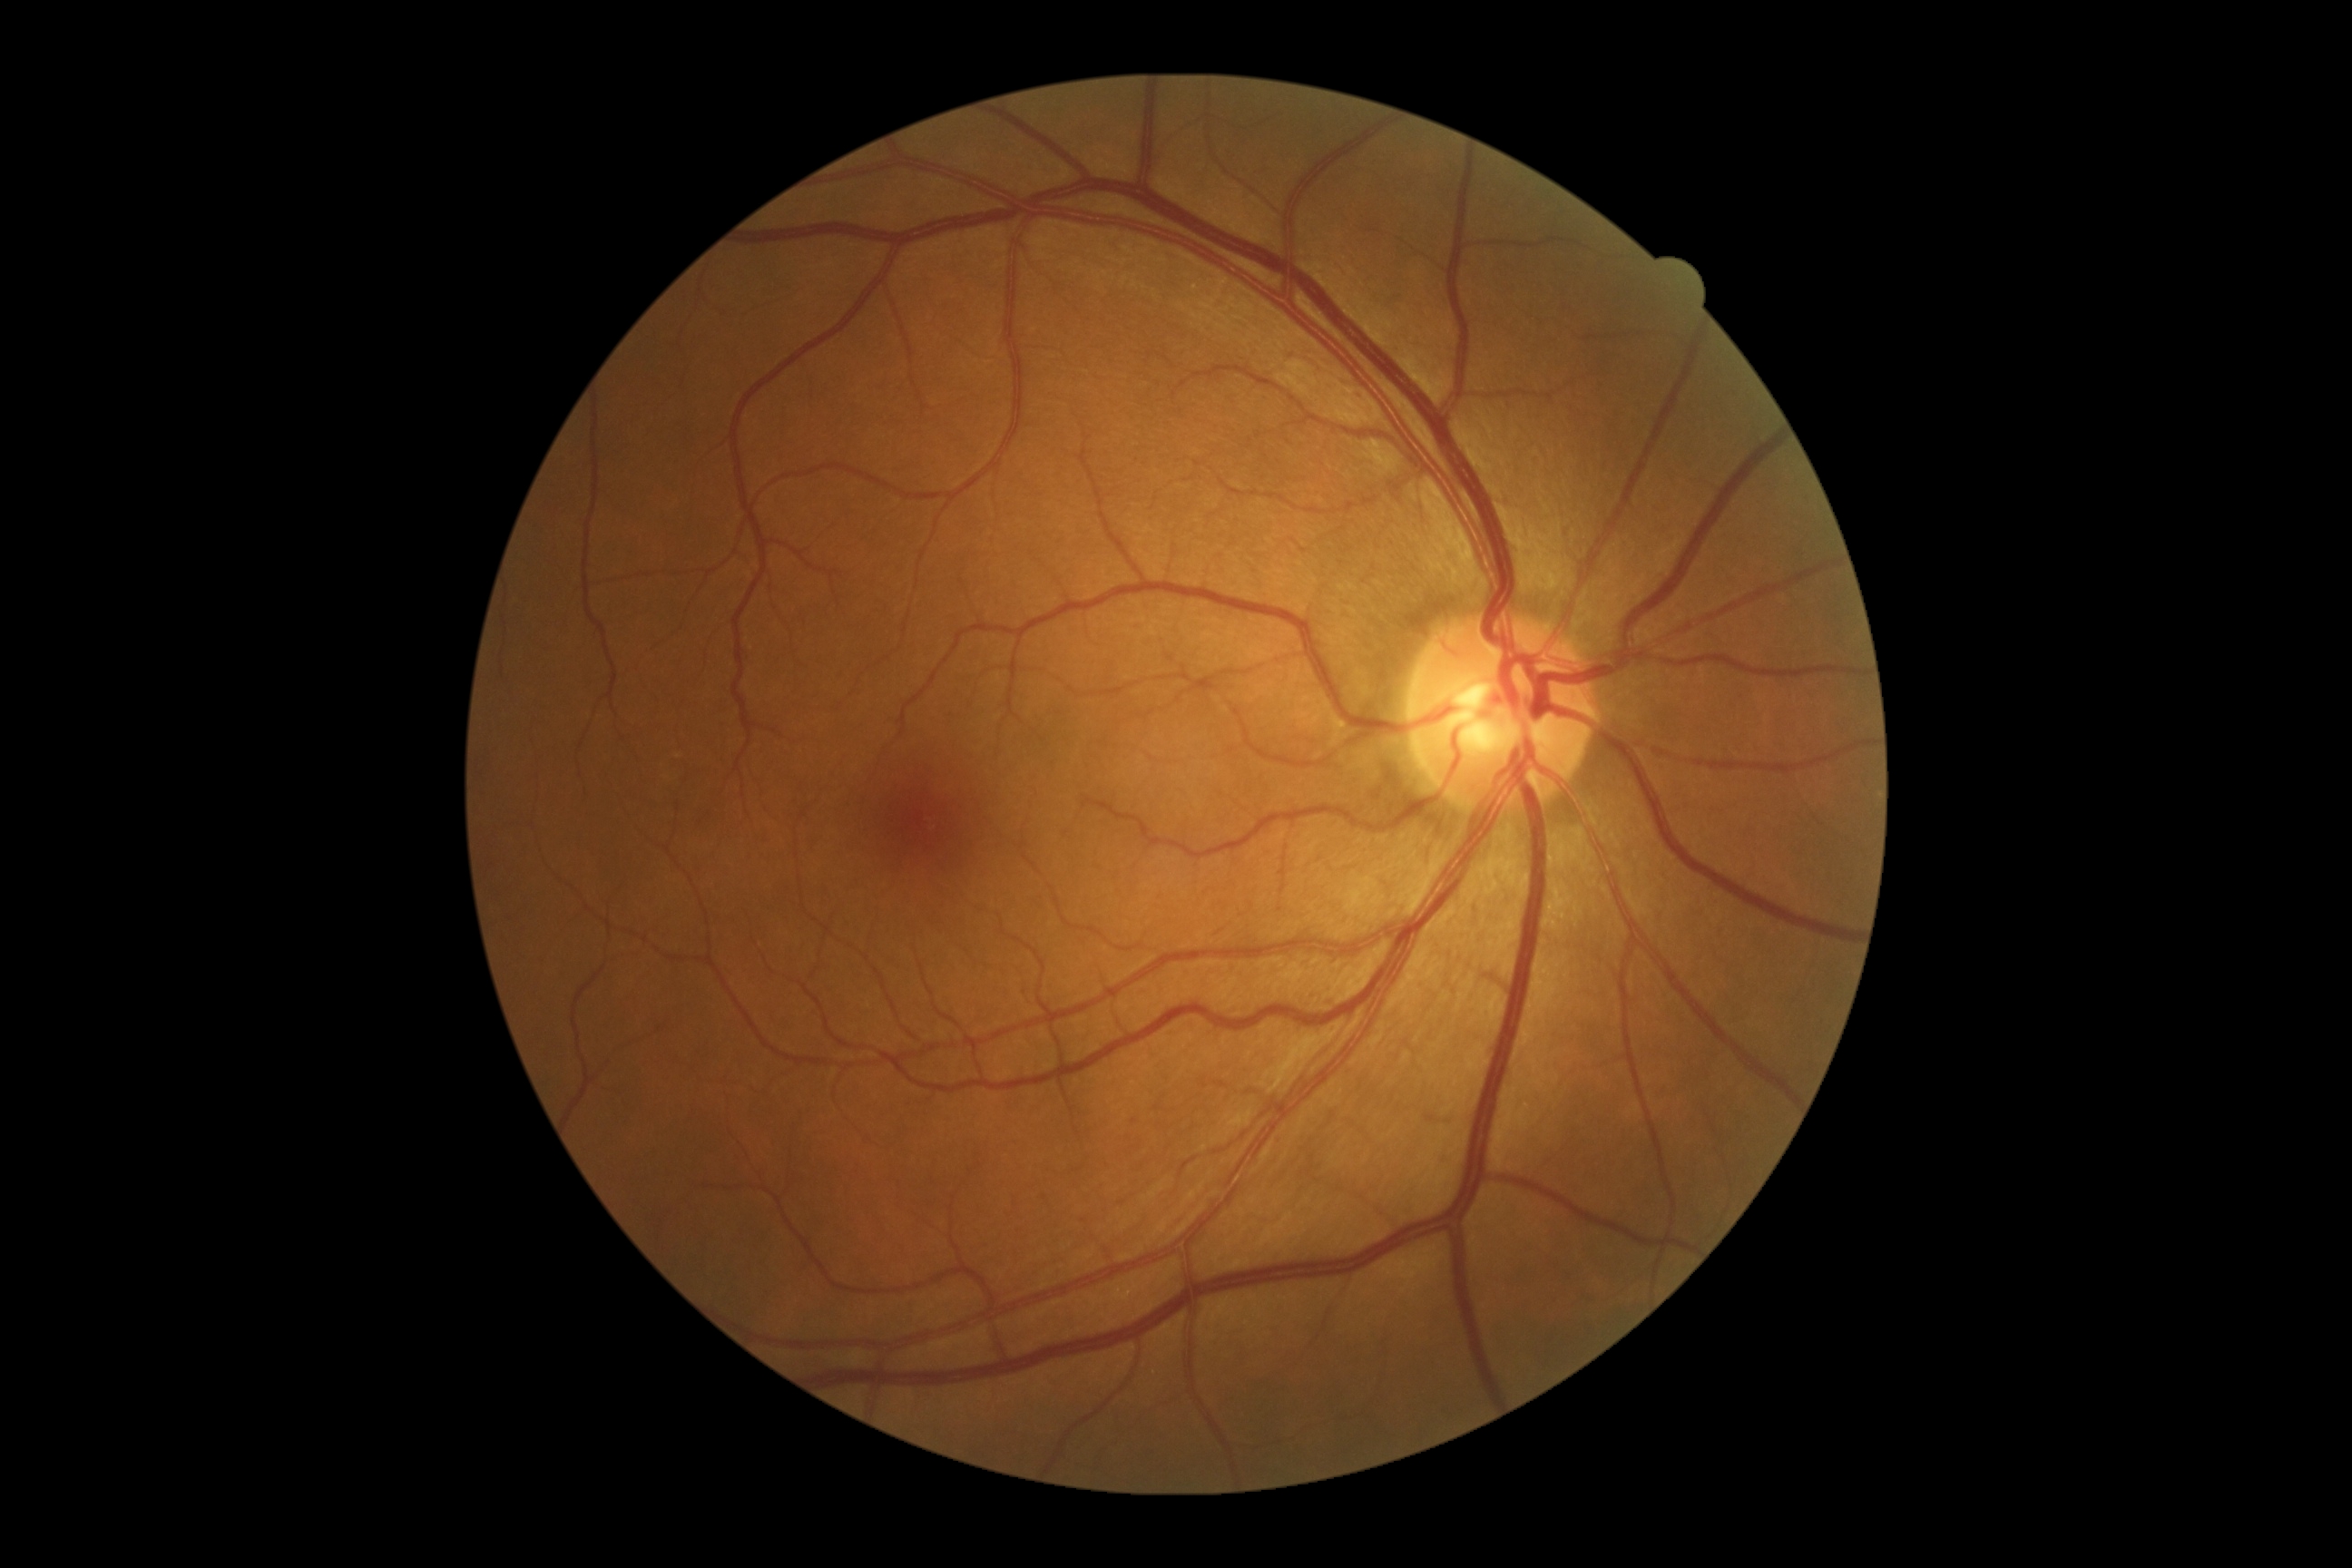

{"dr_impression": "no apparent DR", "dr_grade": "0/4"}